Image size 1440x1080. Infant wide-field fundus photograph. Captured with the Natus RetCam Envision (130° field of view)
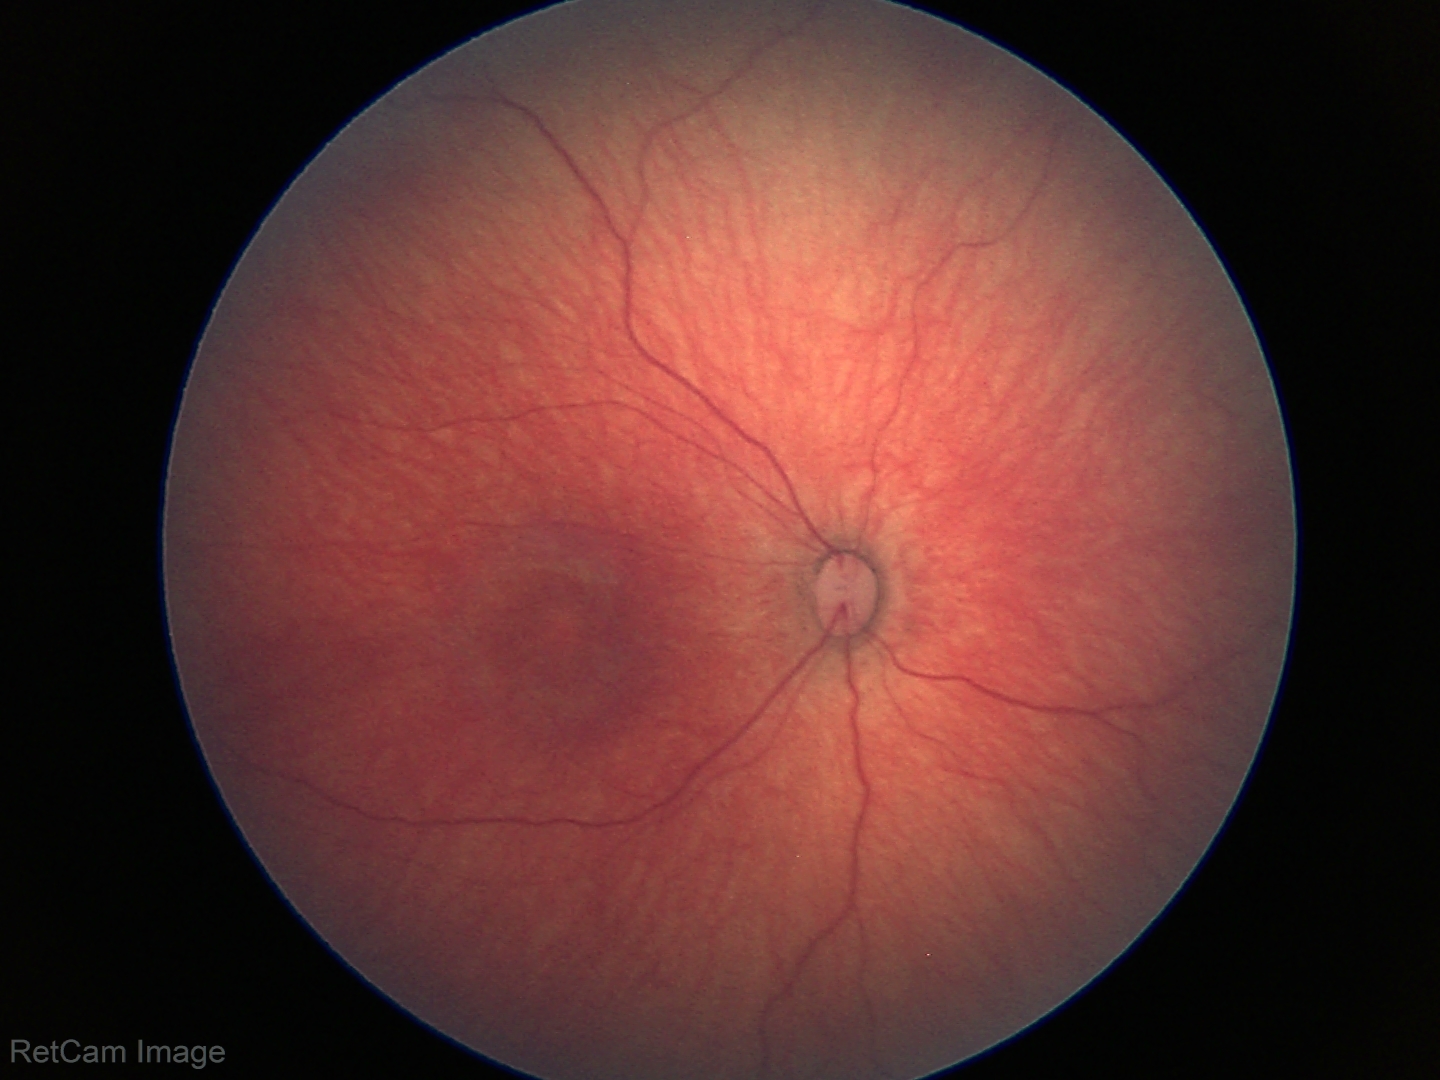 No retinal pathology identified on screening.